NIDEK AFC-230; FOV: 45 degrees:
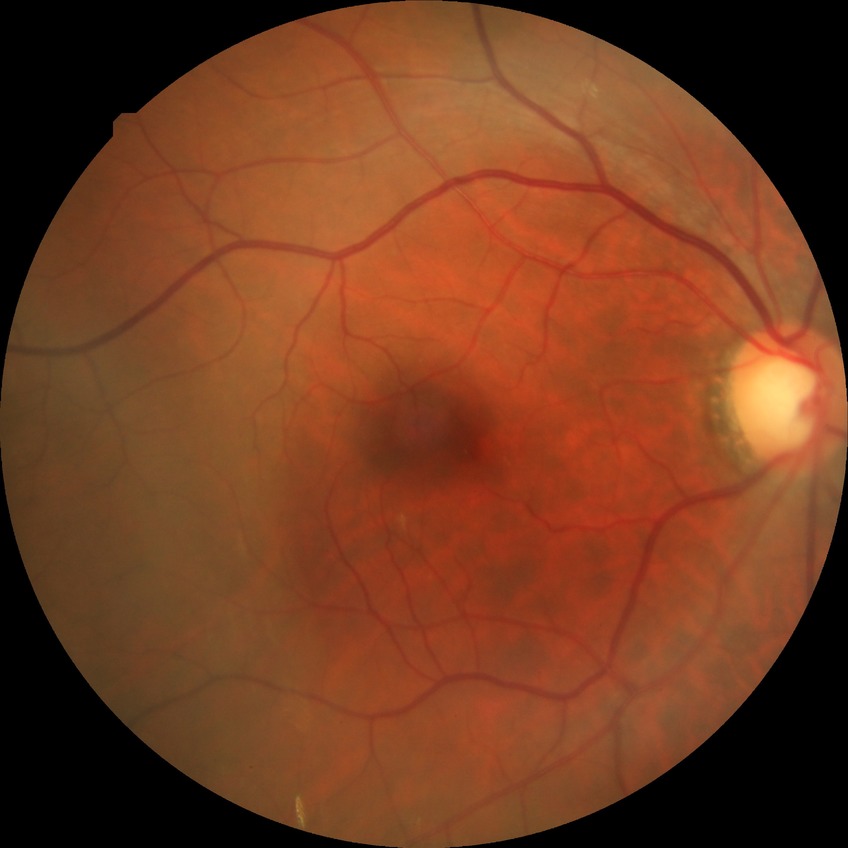

Modified Davis grading: no diabetic retinopathy.